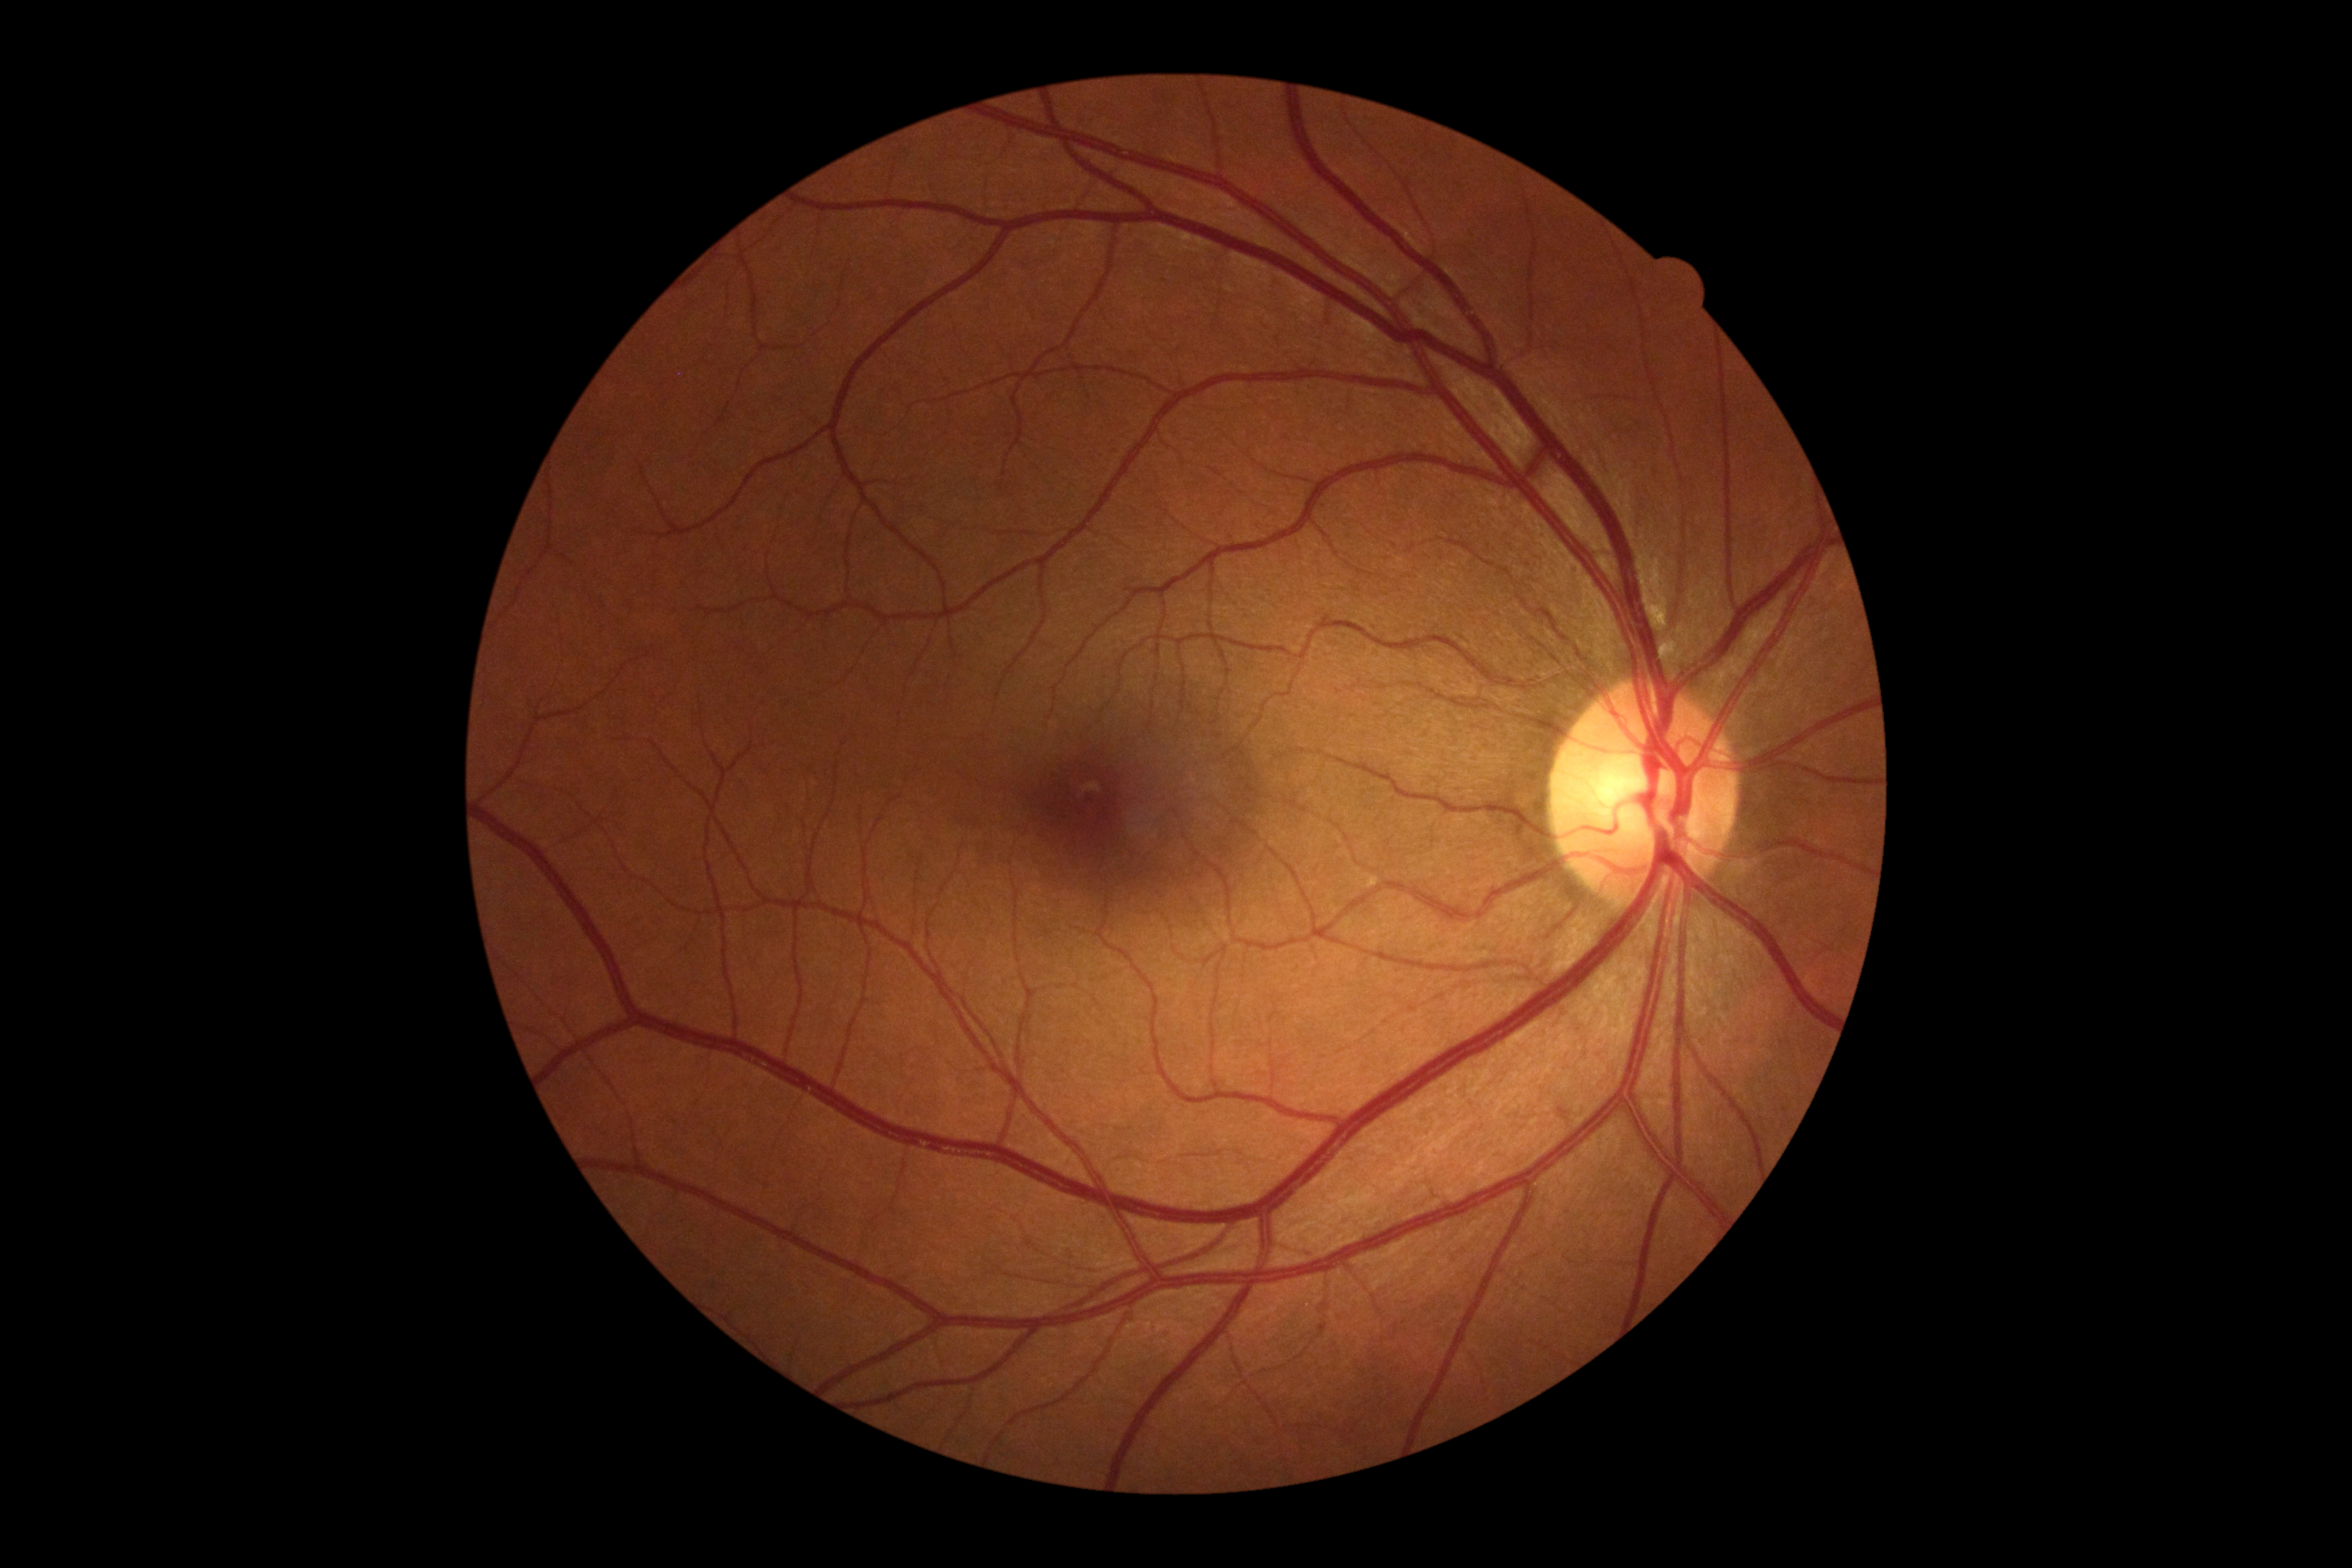
DR severity is 0 — no visible signs of diabetic retinopathy.